2352x1568px — 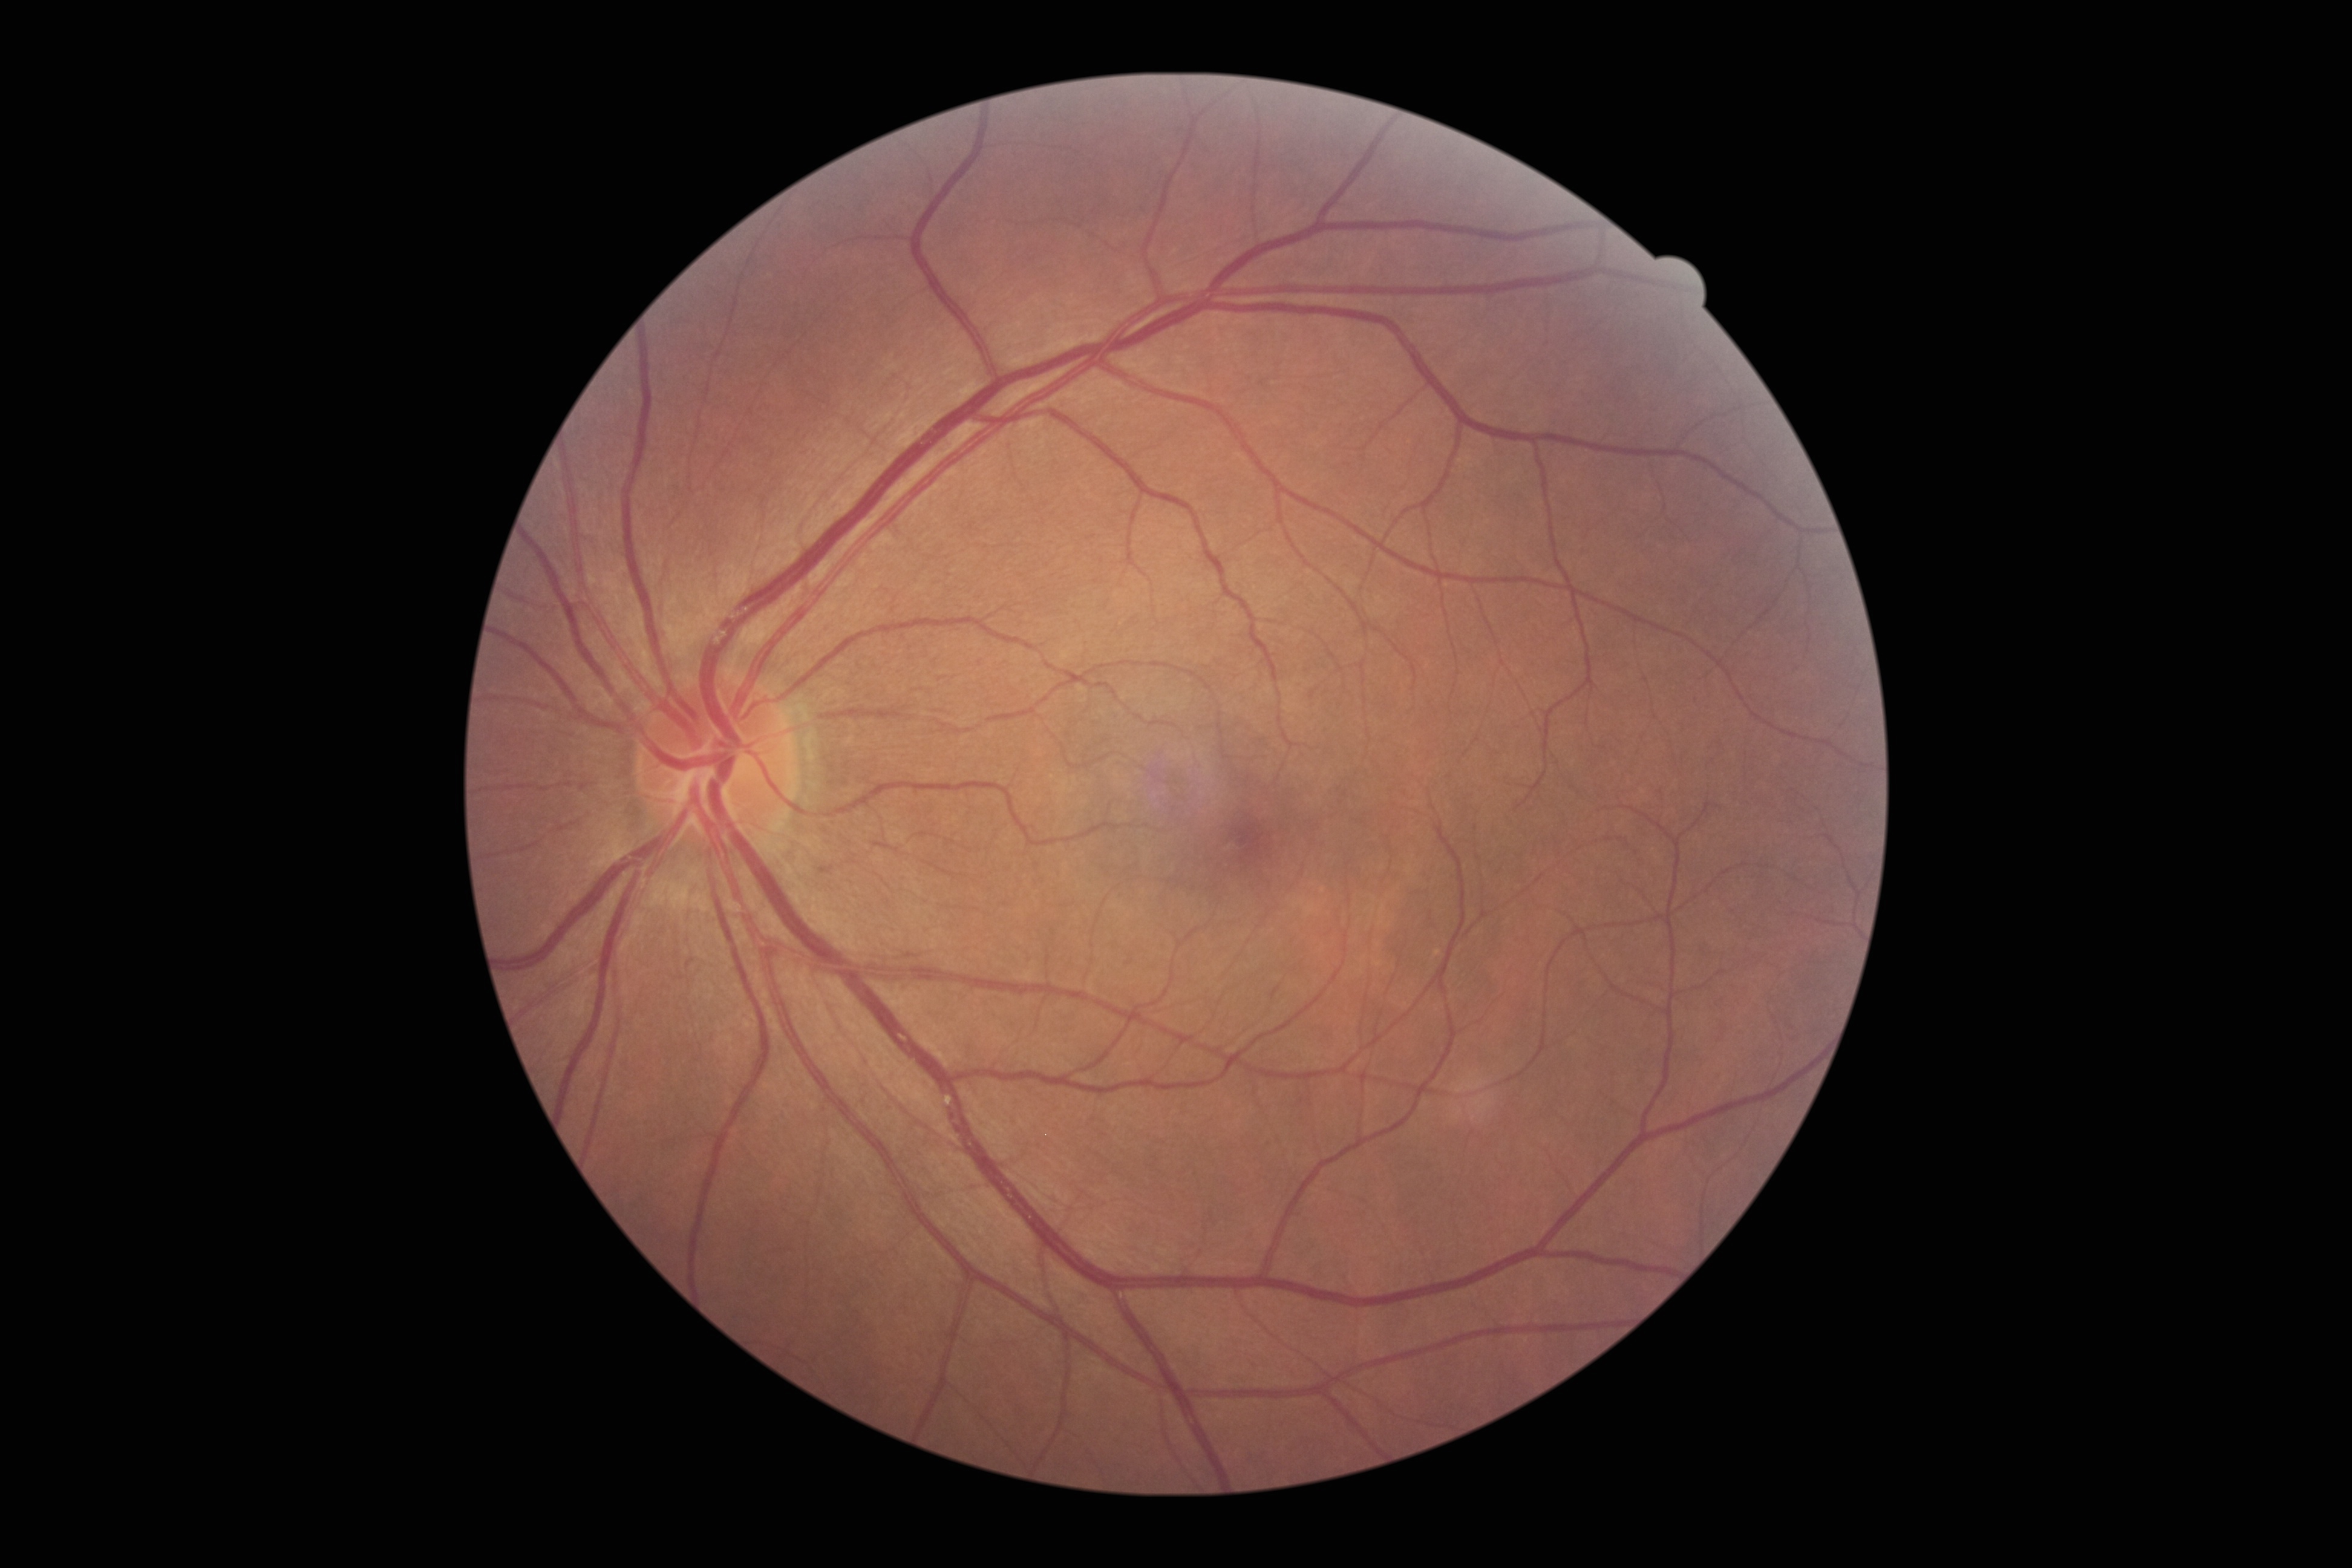

diabetic retinopathy (DR)@grade 0.